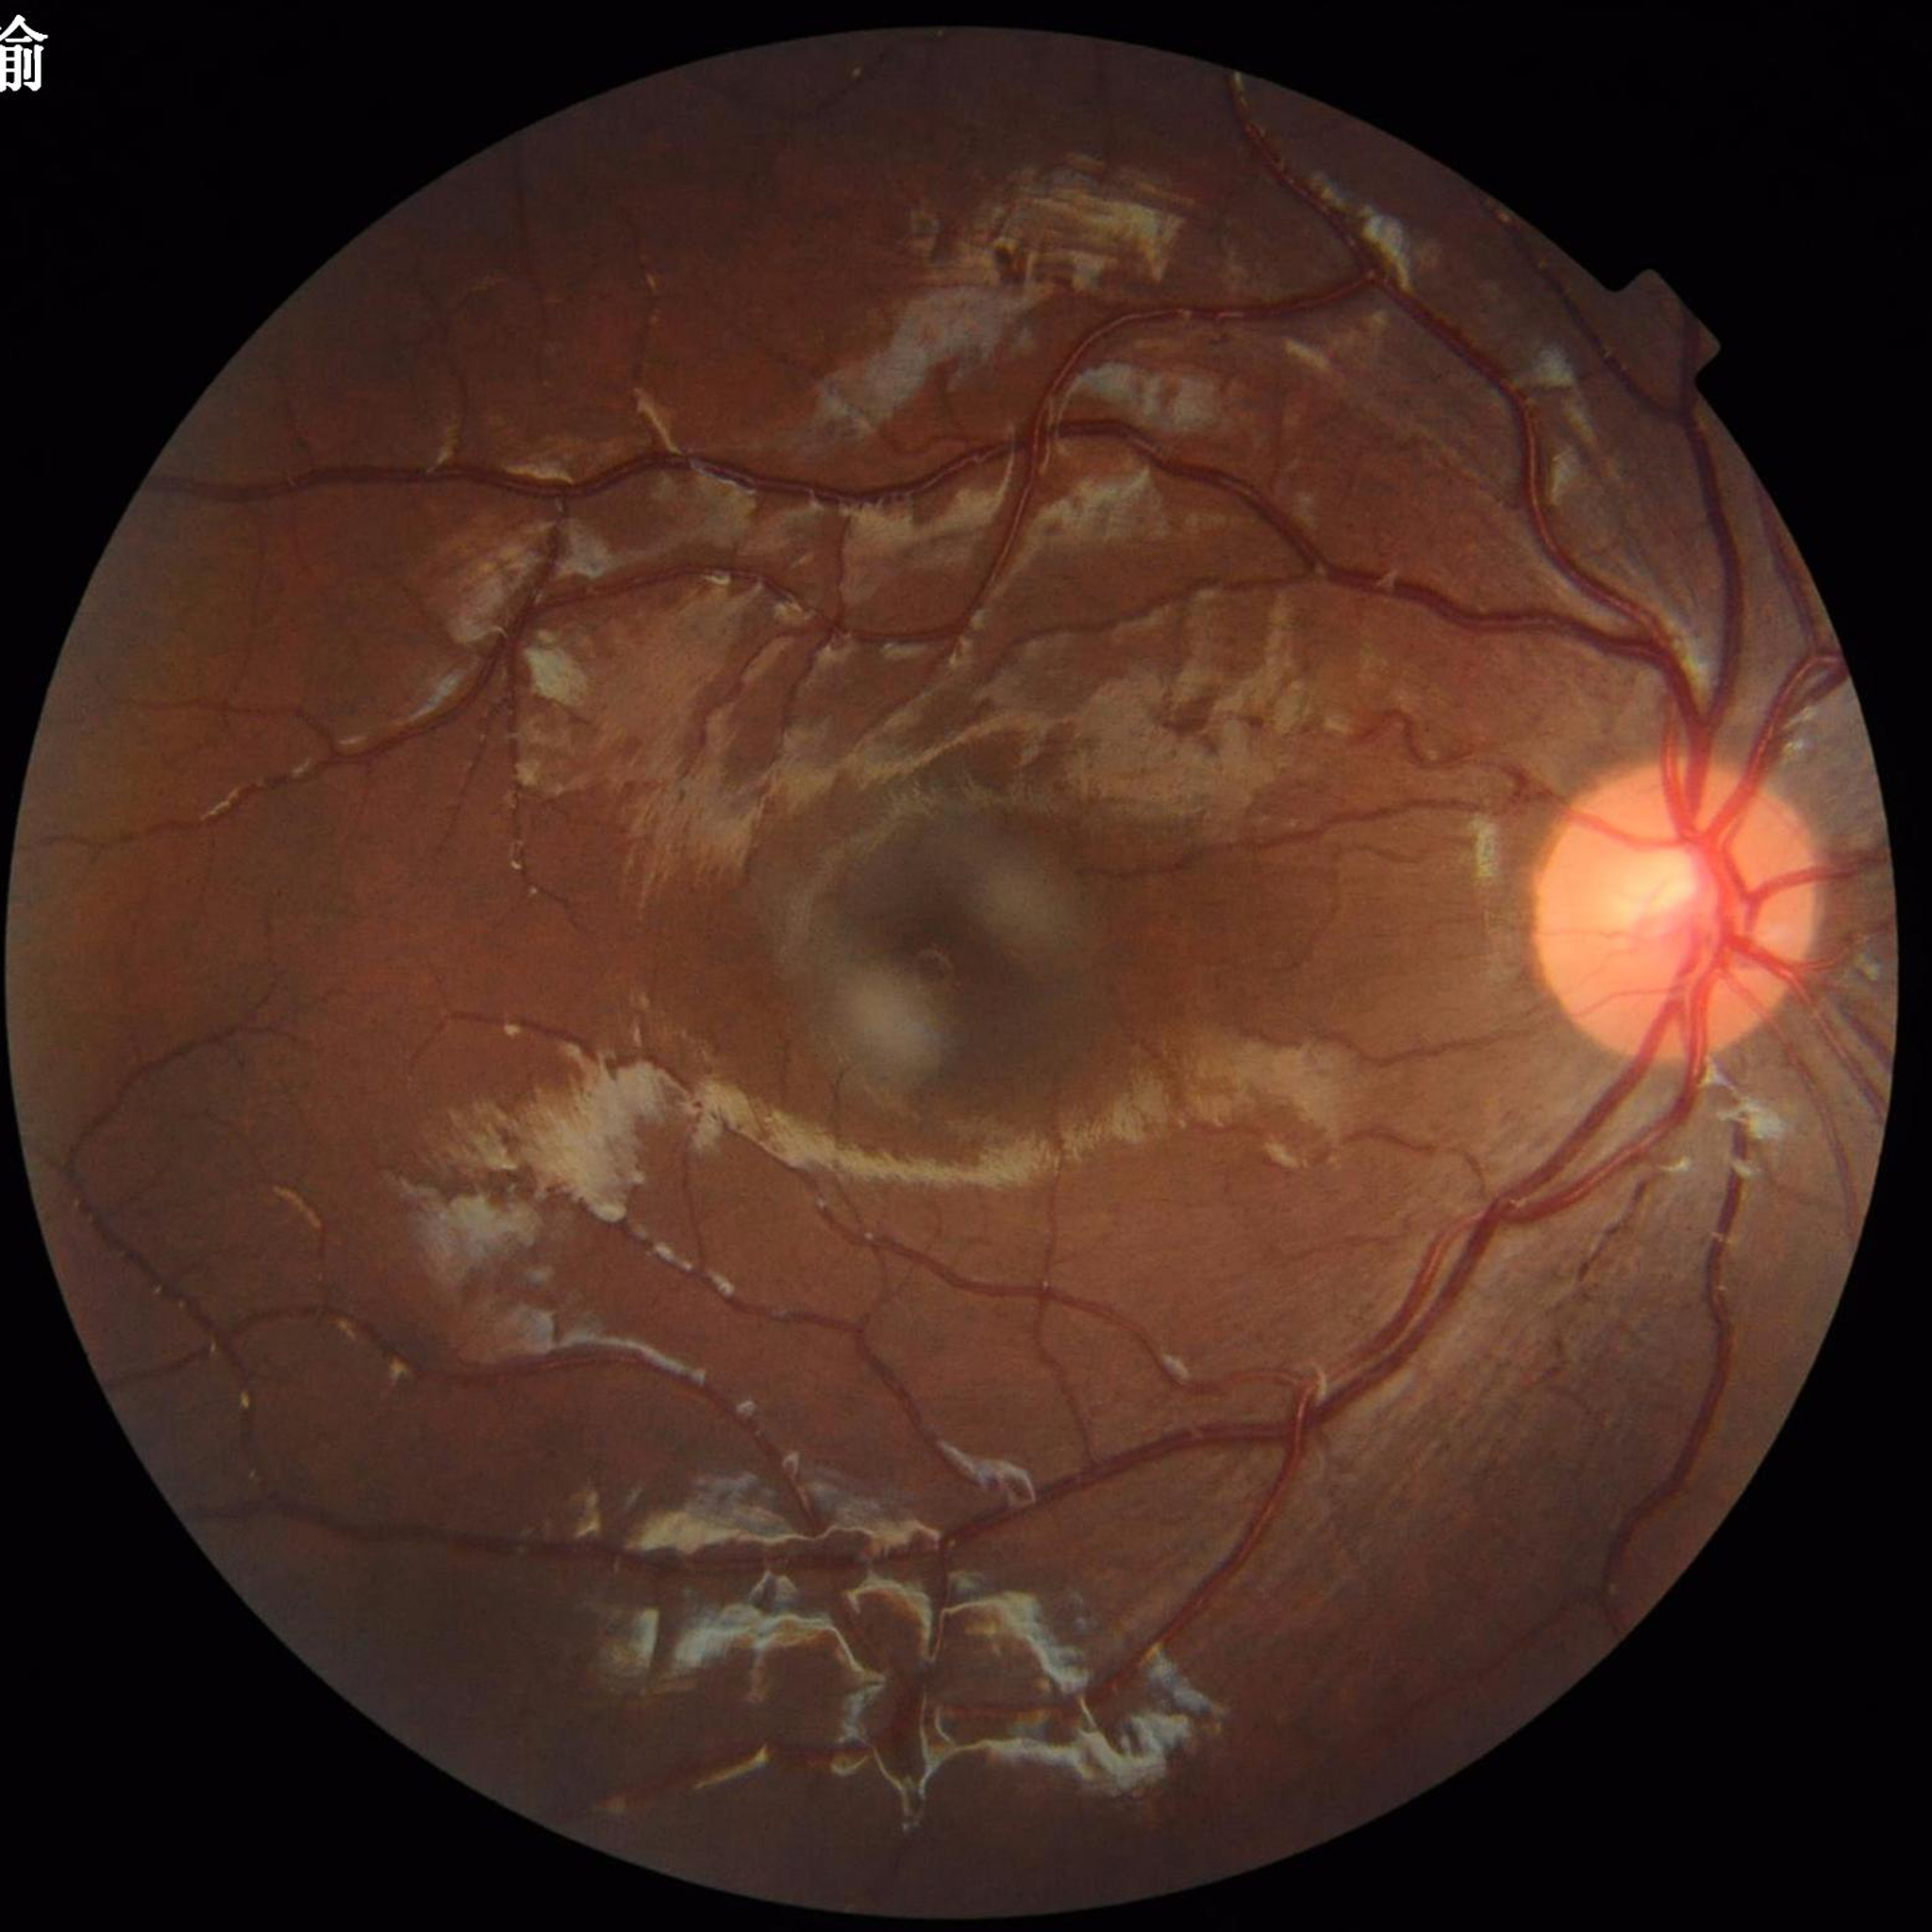 No signs of AMD, diabetic retinopathy, or glaucoma.
Quality: no blur, contrast adequate, illumination and color satisfactory.